Fundus photo. 1536x1152. 45° FOV.
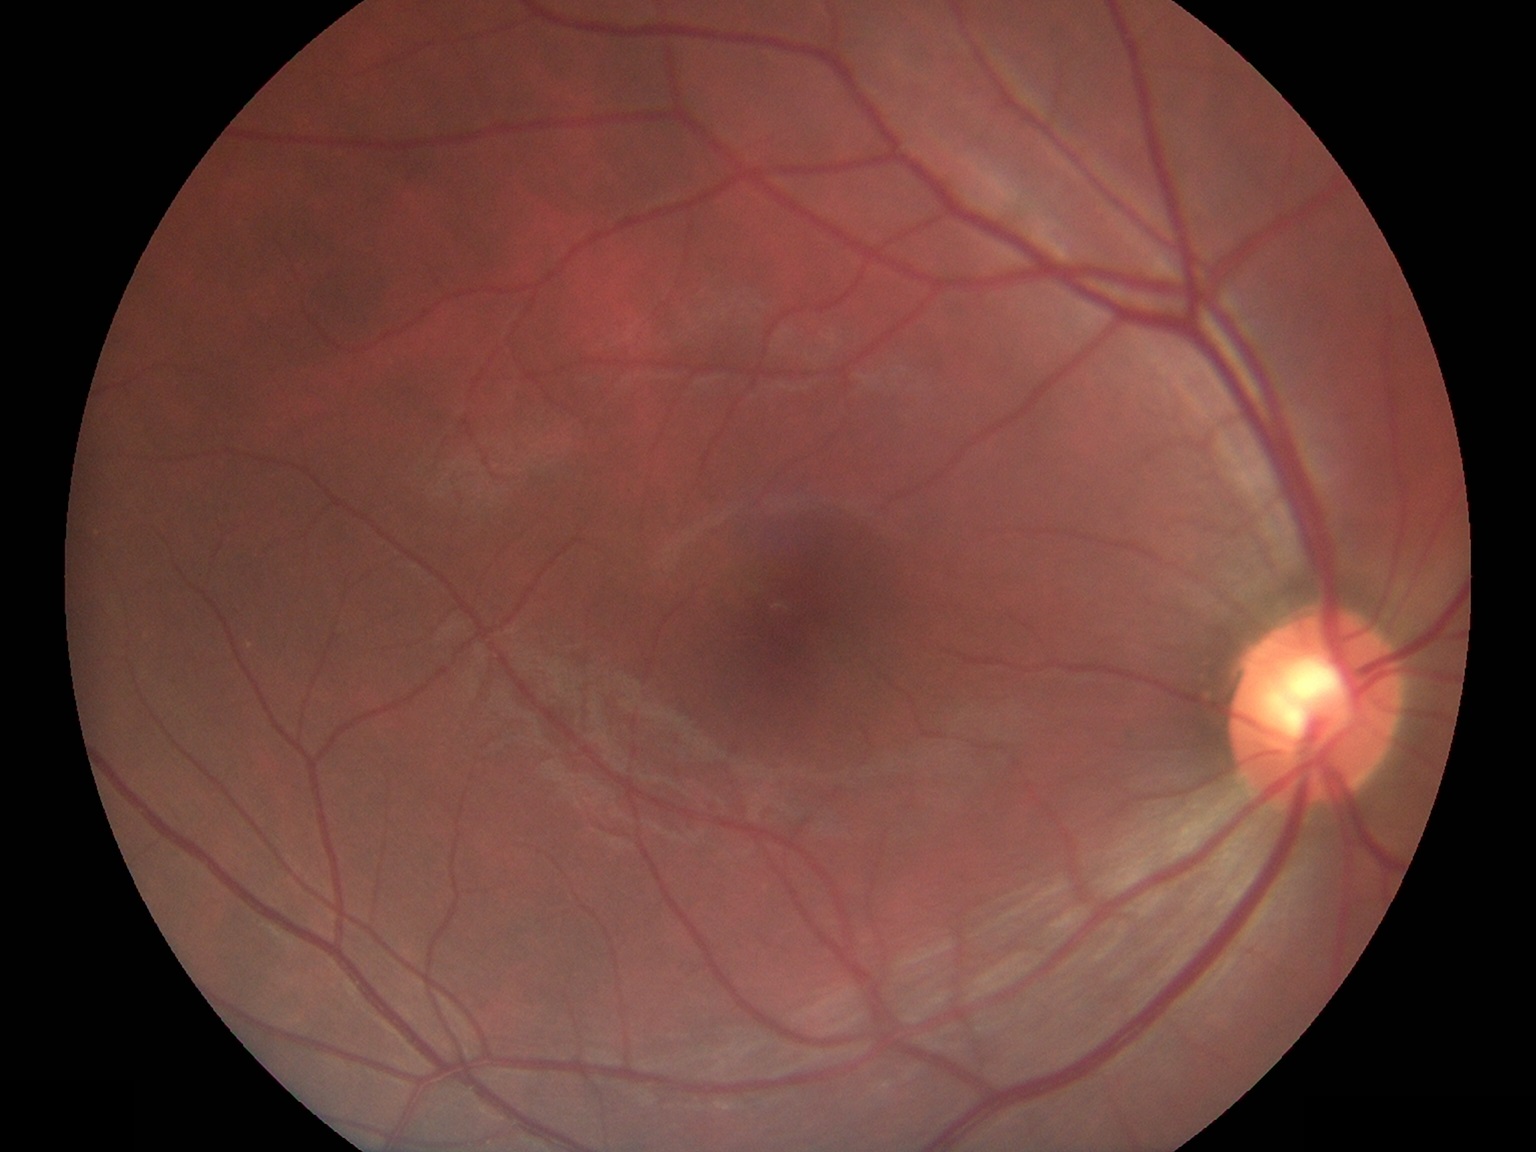
  dr_grade: no apparent retinopathy (grade 0)